Retinal fundus photograph:
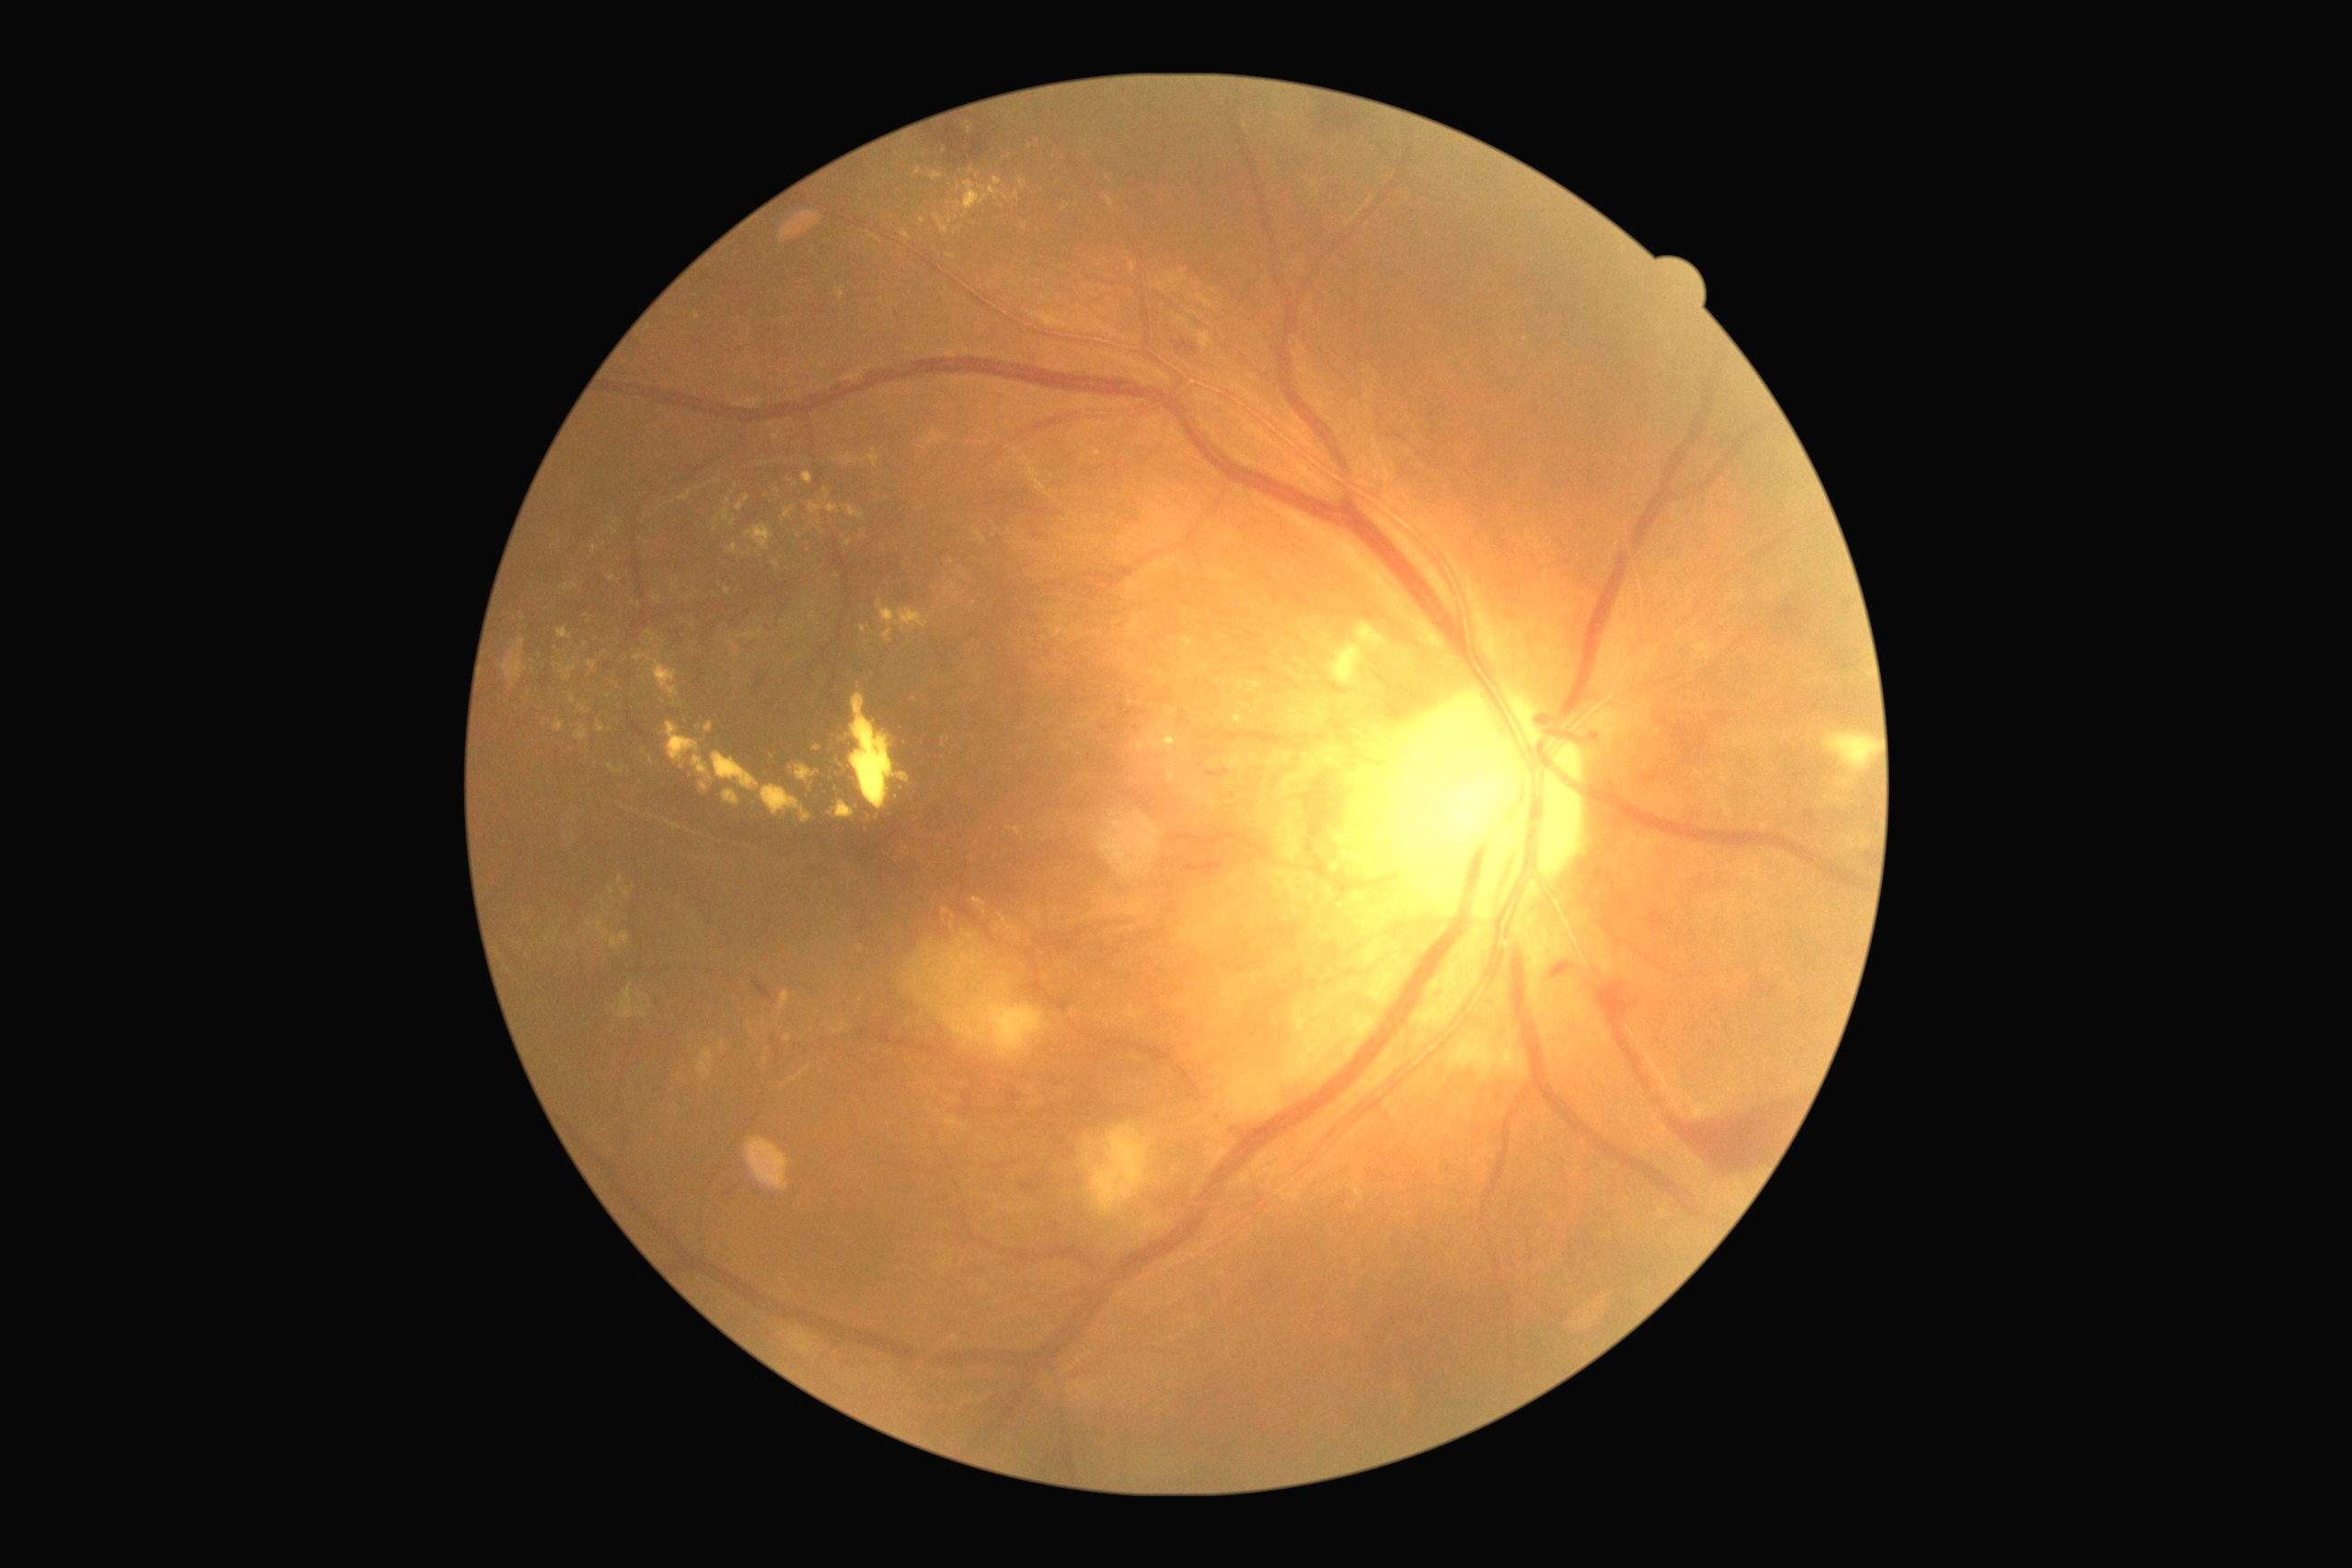 Diabetic retinopathy (DR): grade 4 (PDR)
Representative lesions:
hard exudates (EXs) (partial): (825,489,830,502) | (634,647,662,663) | (576,725,589,741) | (779,1084,787,1088) | (1017,179,1028,190) | (705,723,714,734) | (972,897,986,908) | (1135,721,1179,752) | (1237,681,1262,694) | (607,573,616,582) | (774,562,779,571) | (943,740,950,749) | (1166,273,1181,286)
Smaller EXs around 790:482 | 639:606 | 1067:747 | 806:606 | 587:941